Image size 848x848; Davis DR grading; 45 degree fundus photograph.
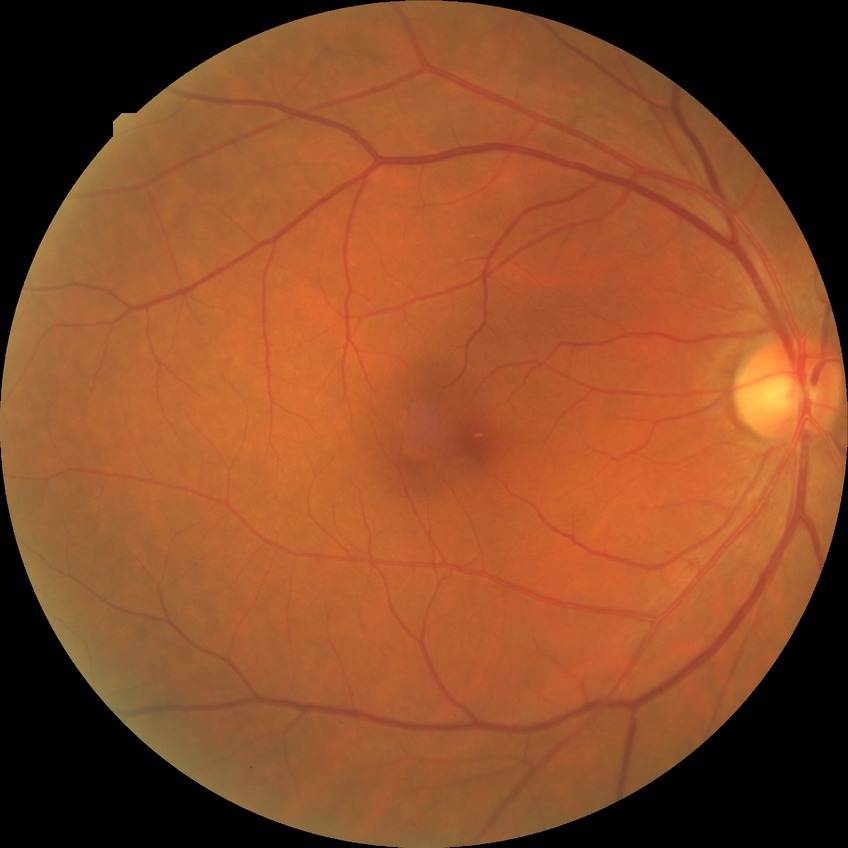

Diabetic retinopathy (DR) is no diabetic retinopathy (NDR).